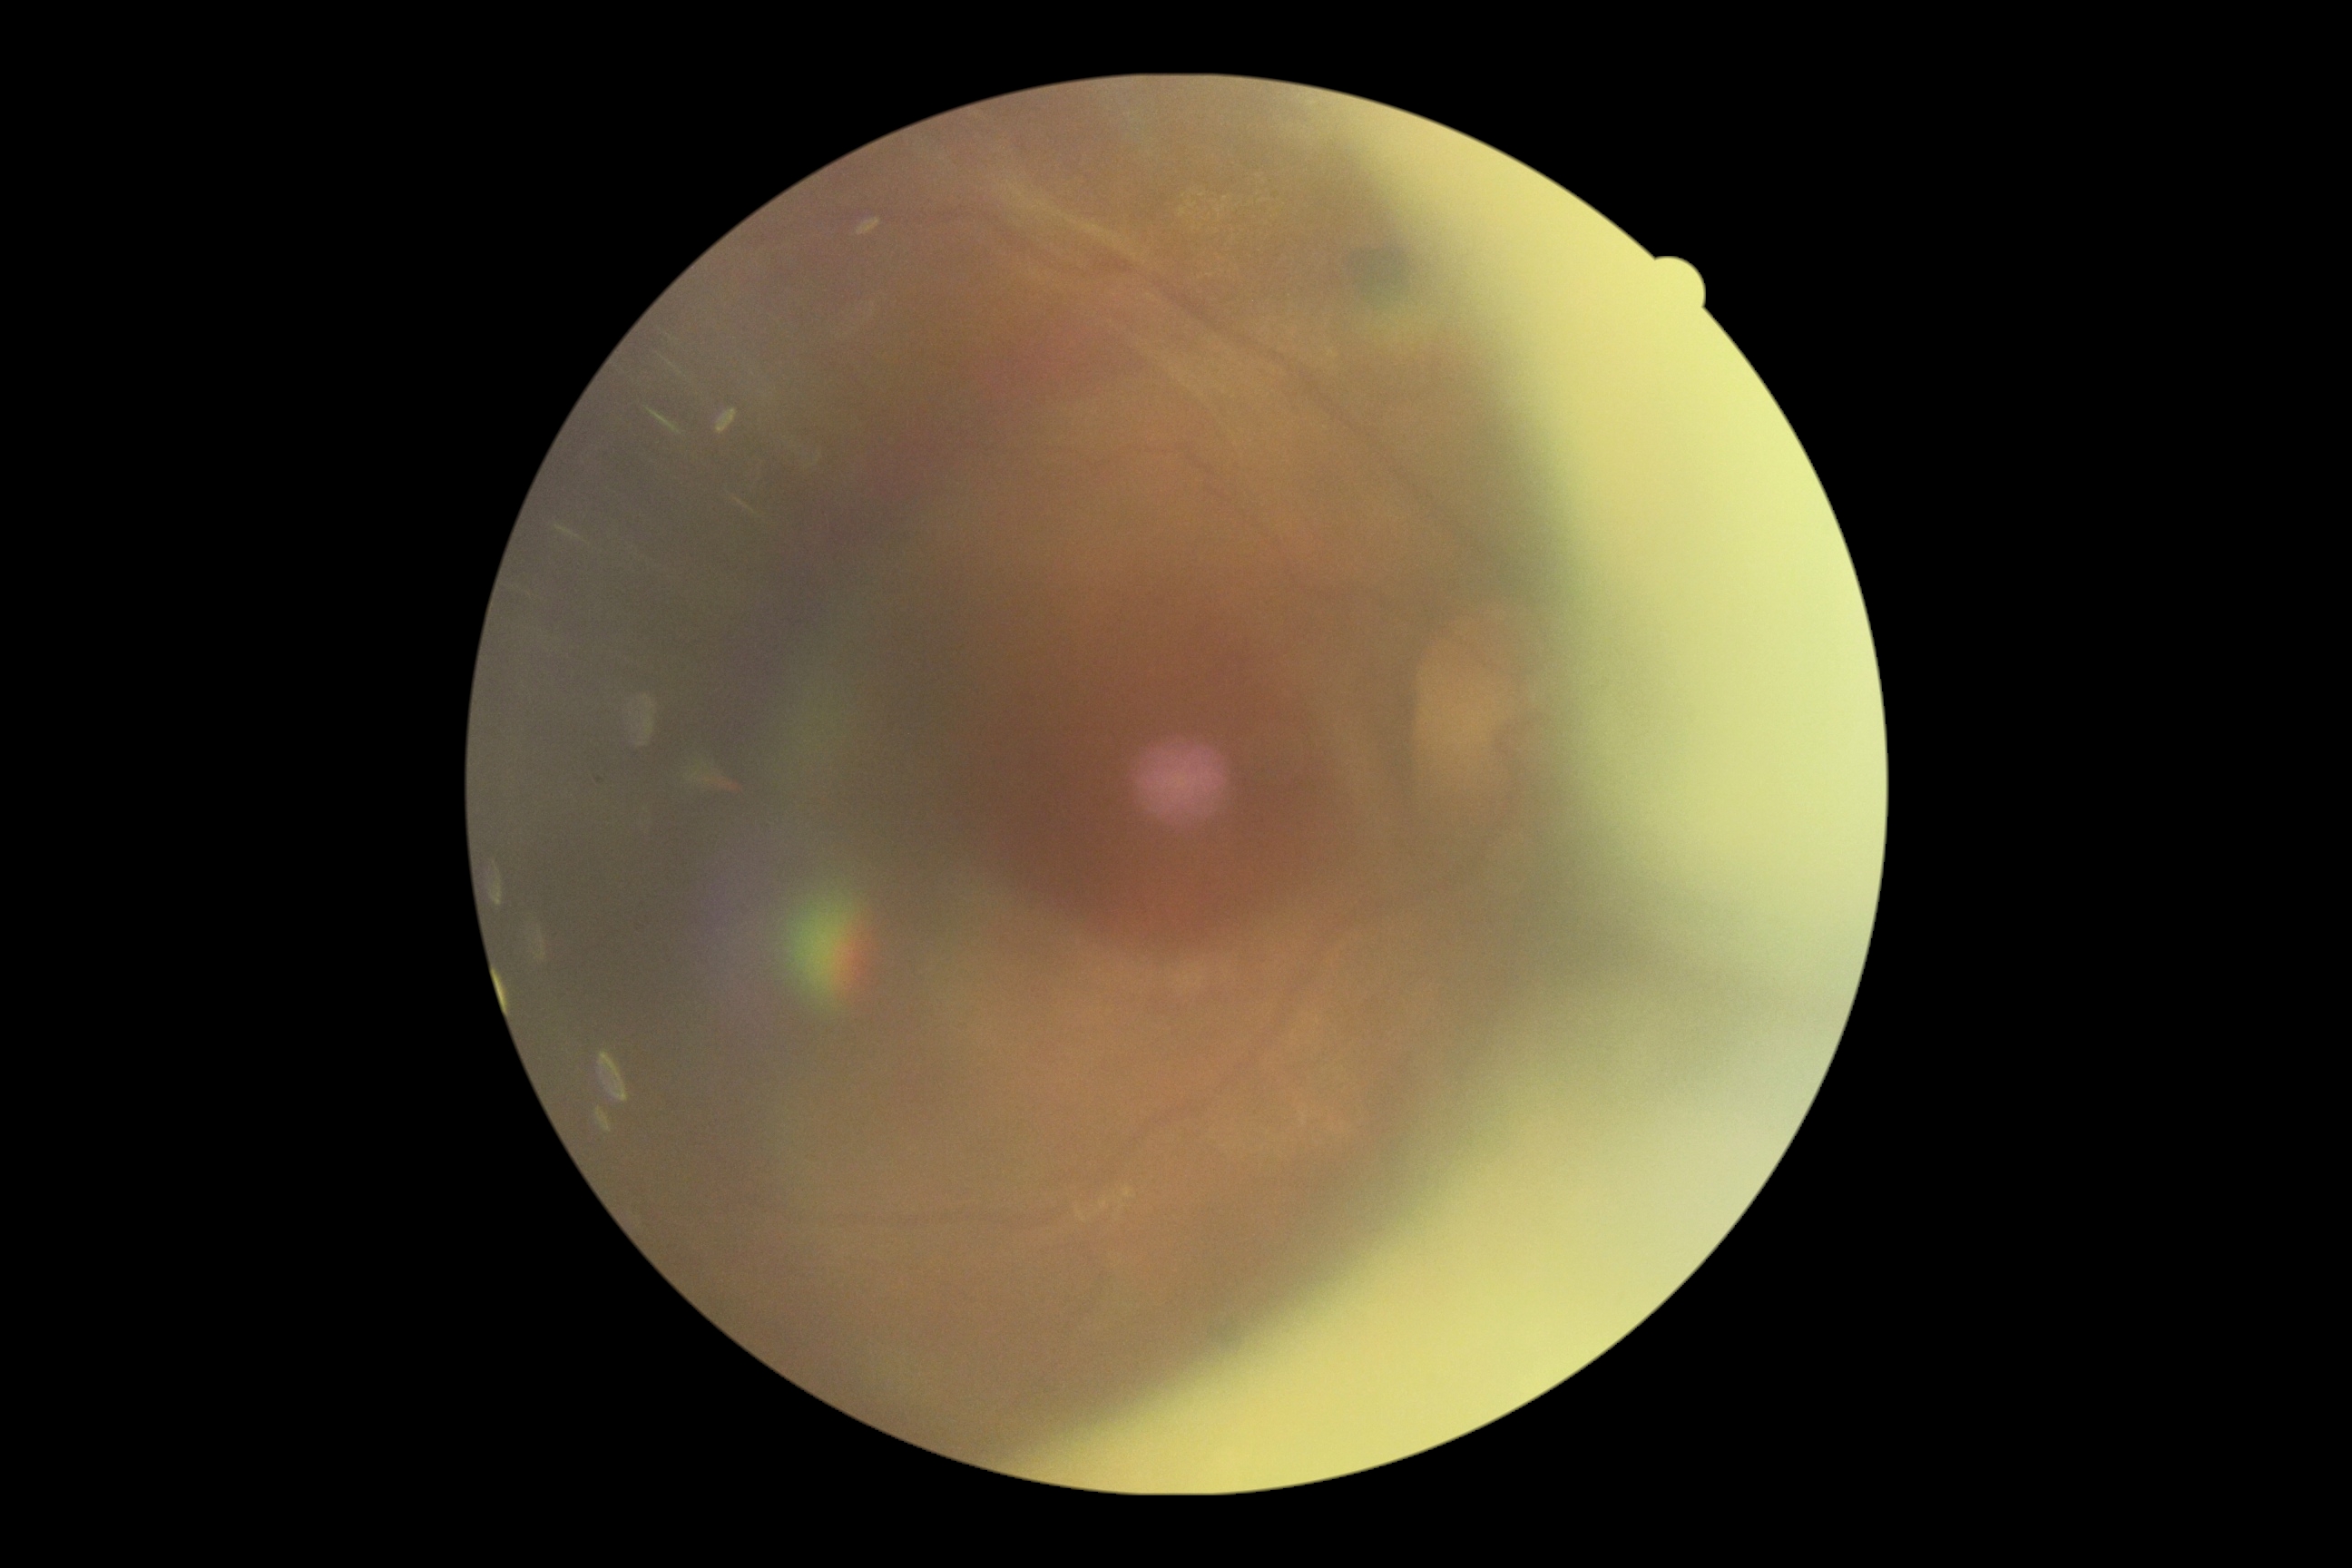 {"dr_grade": "4"}